Diabetic retinopathy graded by the modified Davis classification.
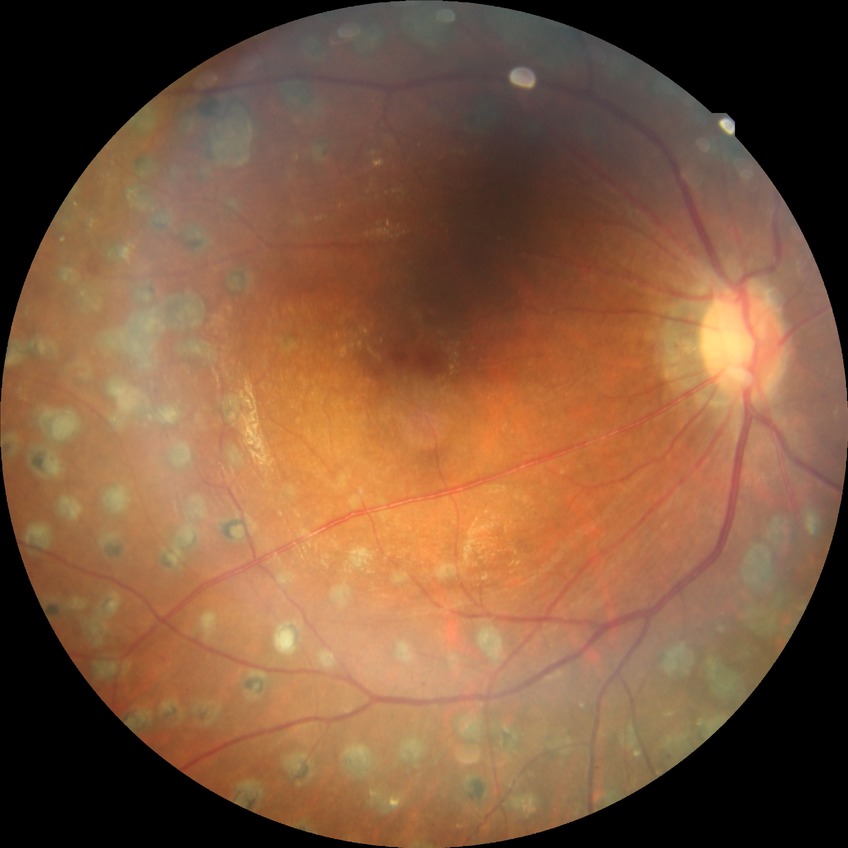
{
  "davis_grade": "PDR"
}